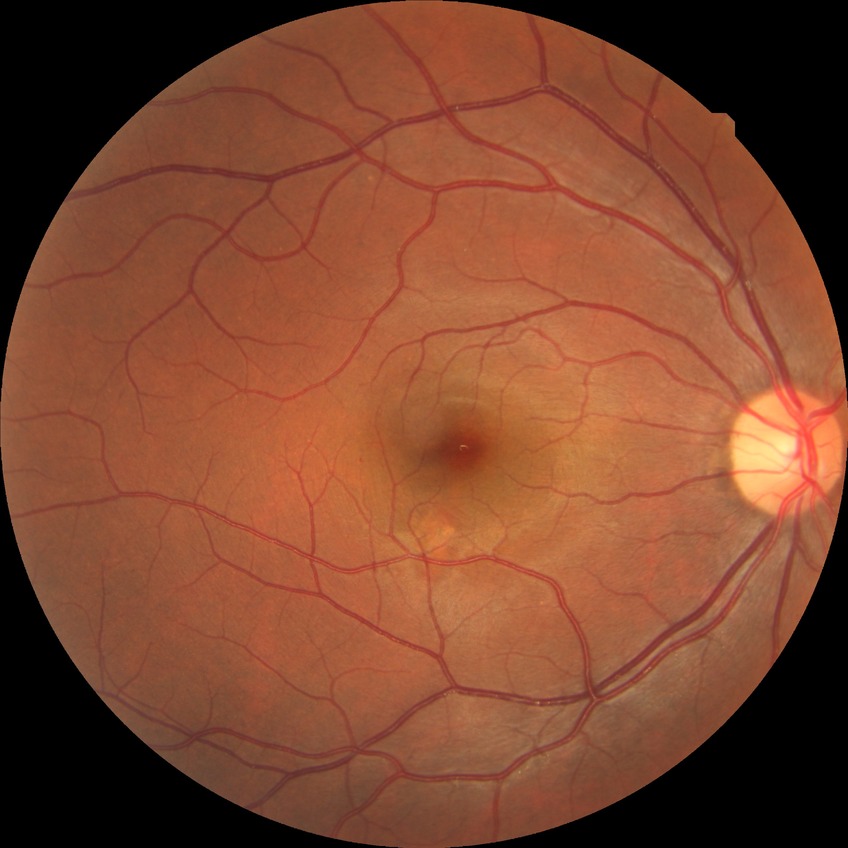
Diabetic retinopathy (DR): NDR (no diabetic retinopathy).